Pediatric wide-field fundus photograph; image size 640x480 — 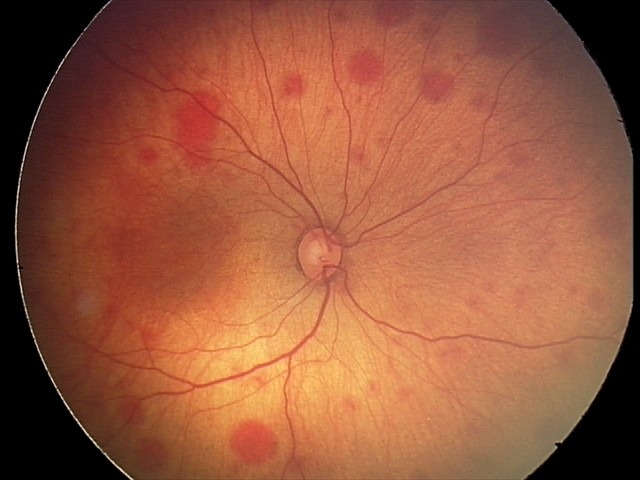
Q: What was the screening finding?
A: retinal hemorrhages